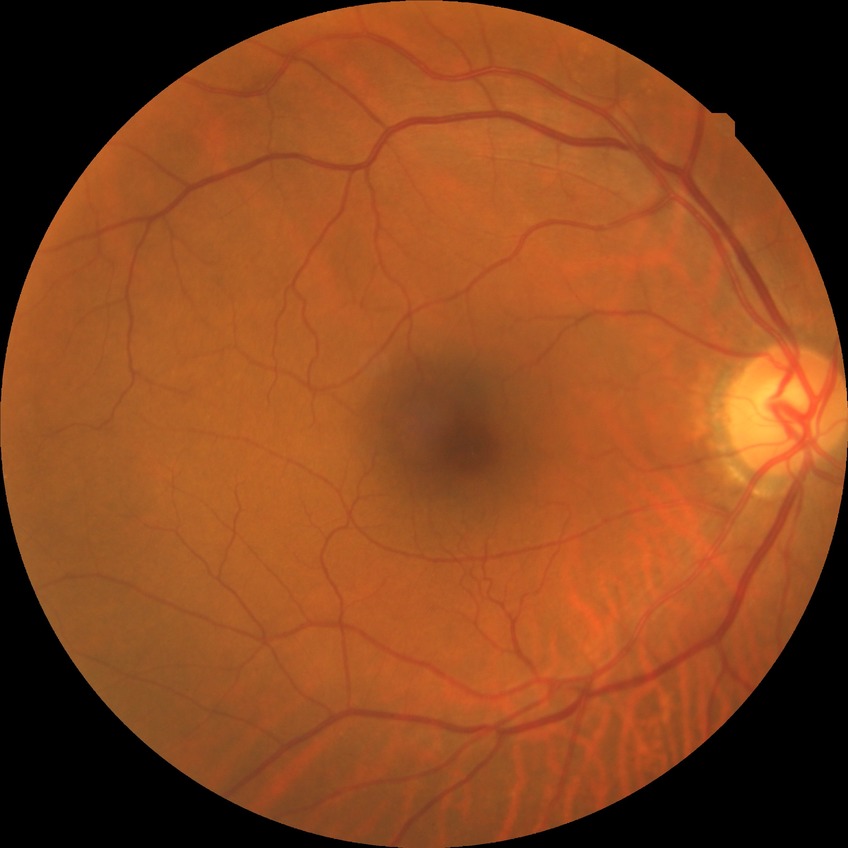

Retinopathy grade is no diabetic retinopathy.